UWF retinal mosaic
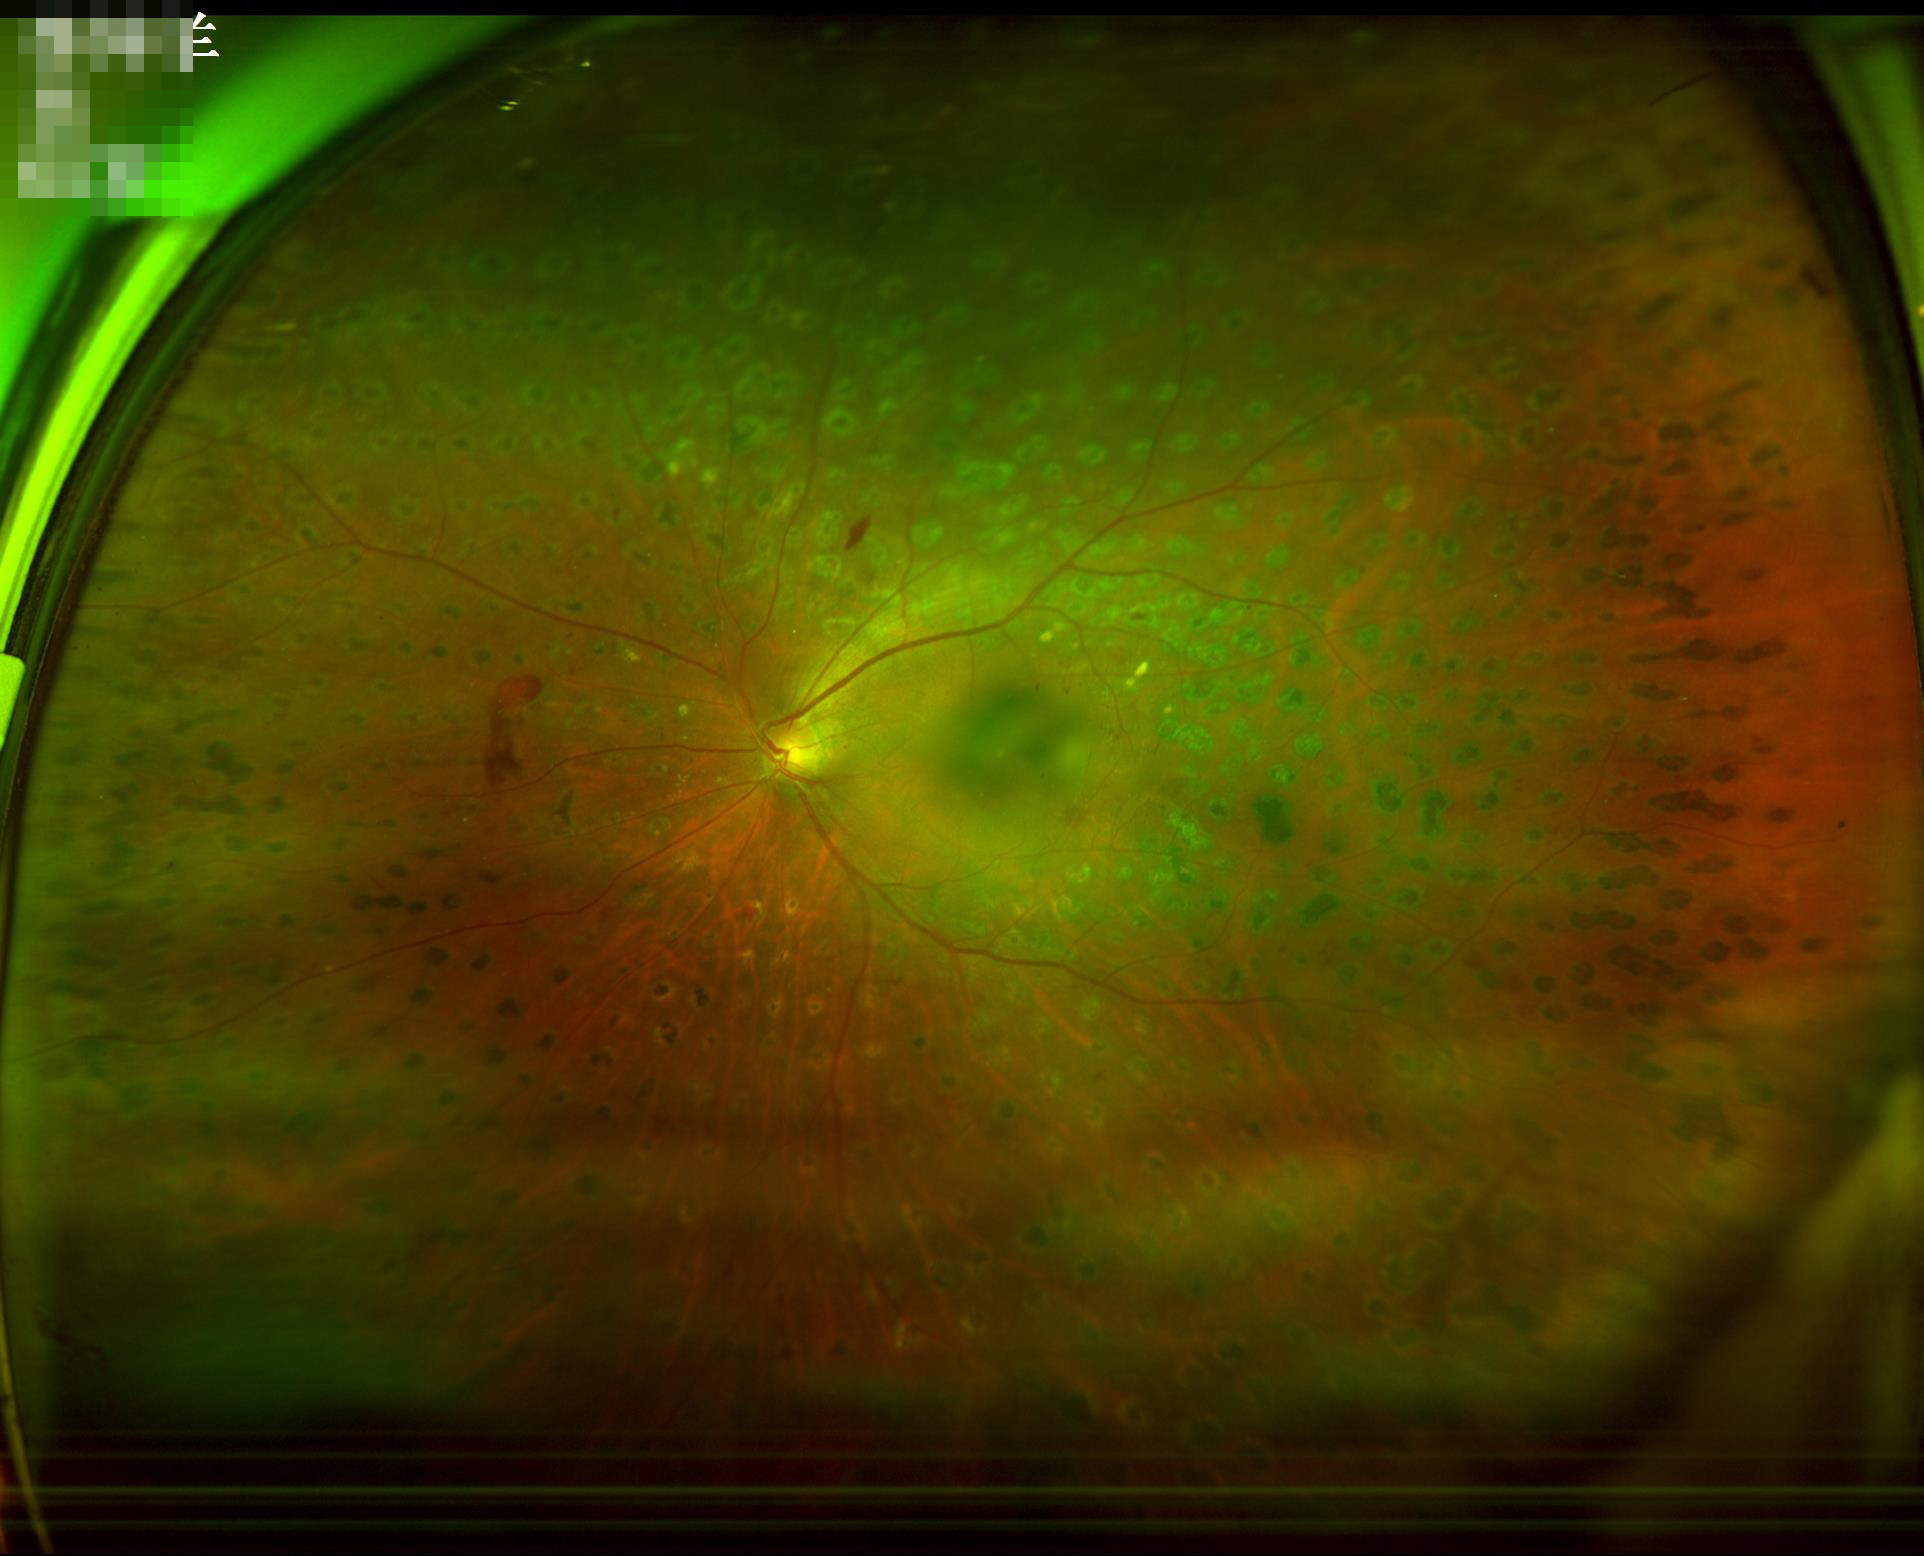
Contrast is good. The image is blurry. Image quality is adequate for diagnostic use.